CFP
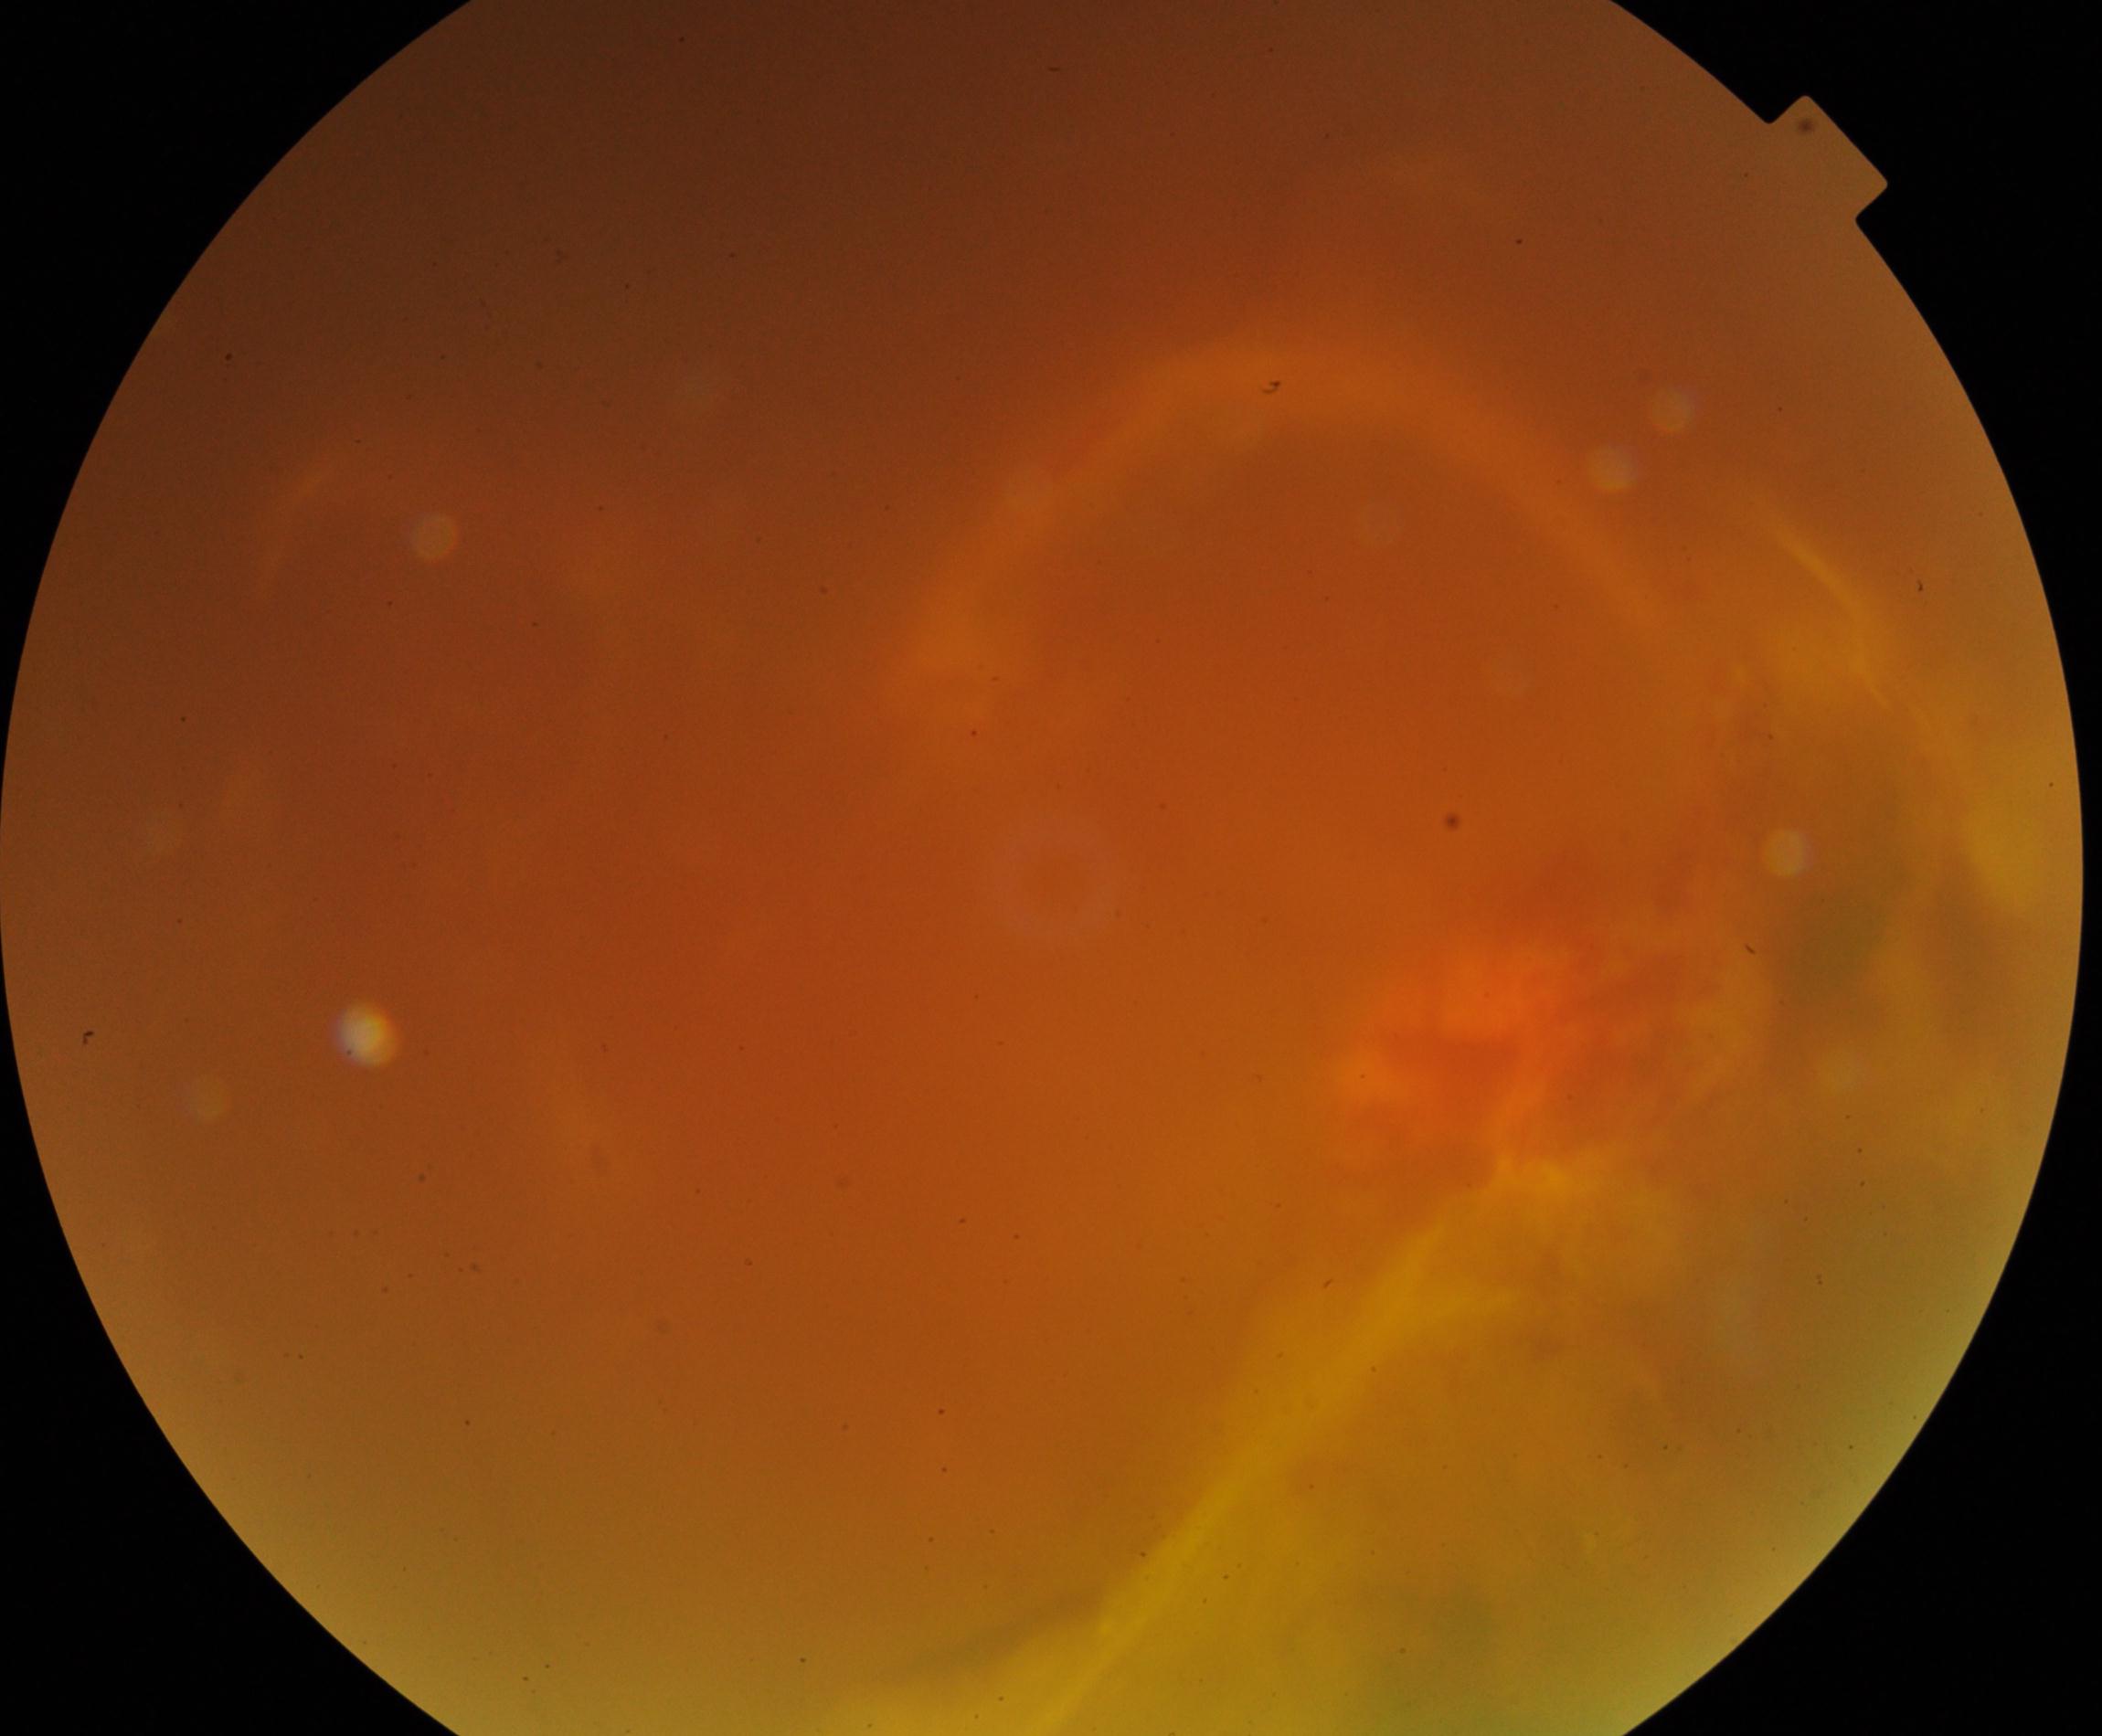

Gradability: poor, substantial obscuration of retinal landmarks. Proliferative retinopathy: suspected, not confirmed.